Modified Davis classification, image size 848x848, nonmydriatic fundus photograph, color fundus image, NIDEK AFC-230, FOV: 45 degrees — 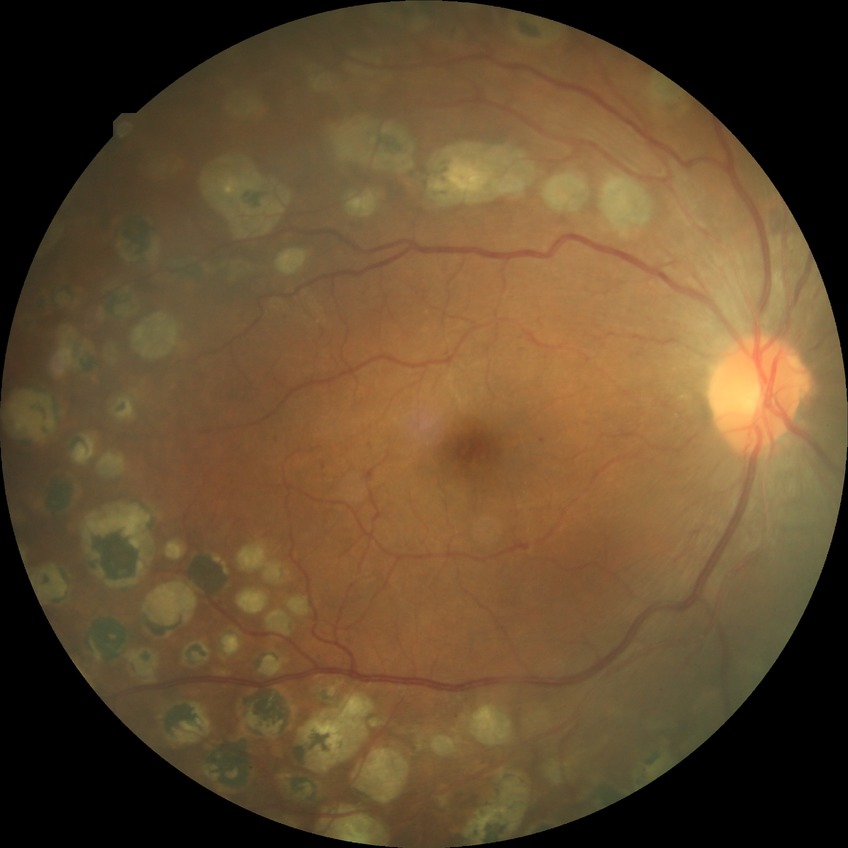 DR: PDR.